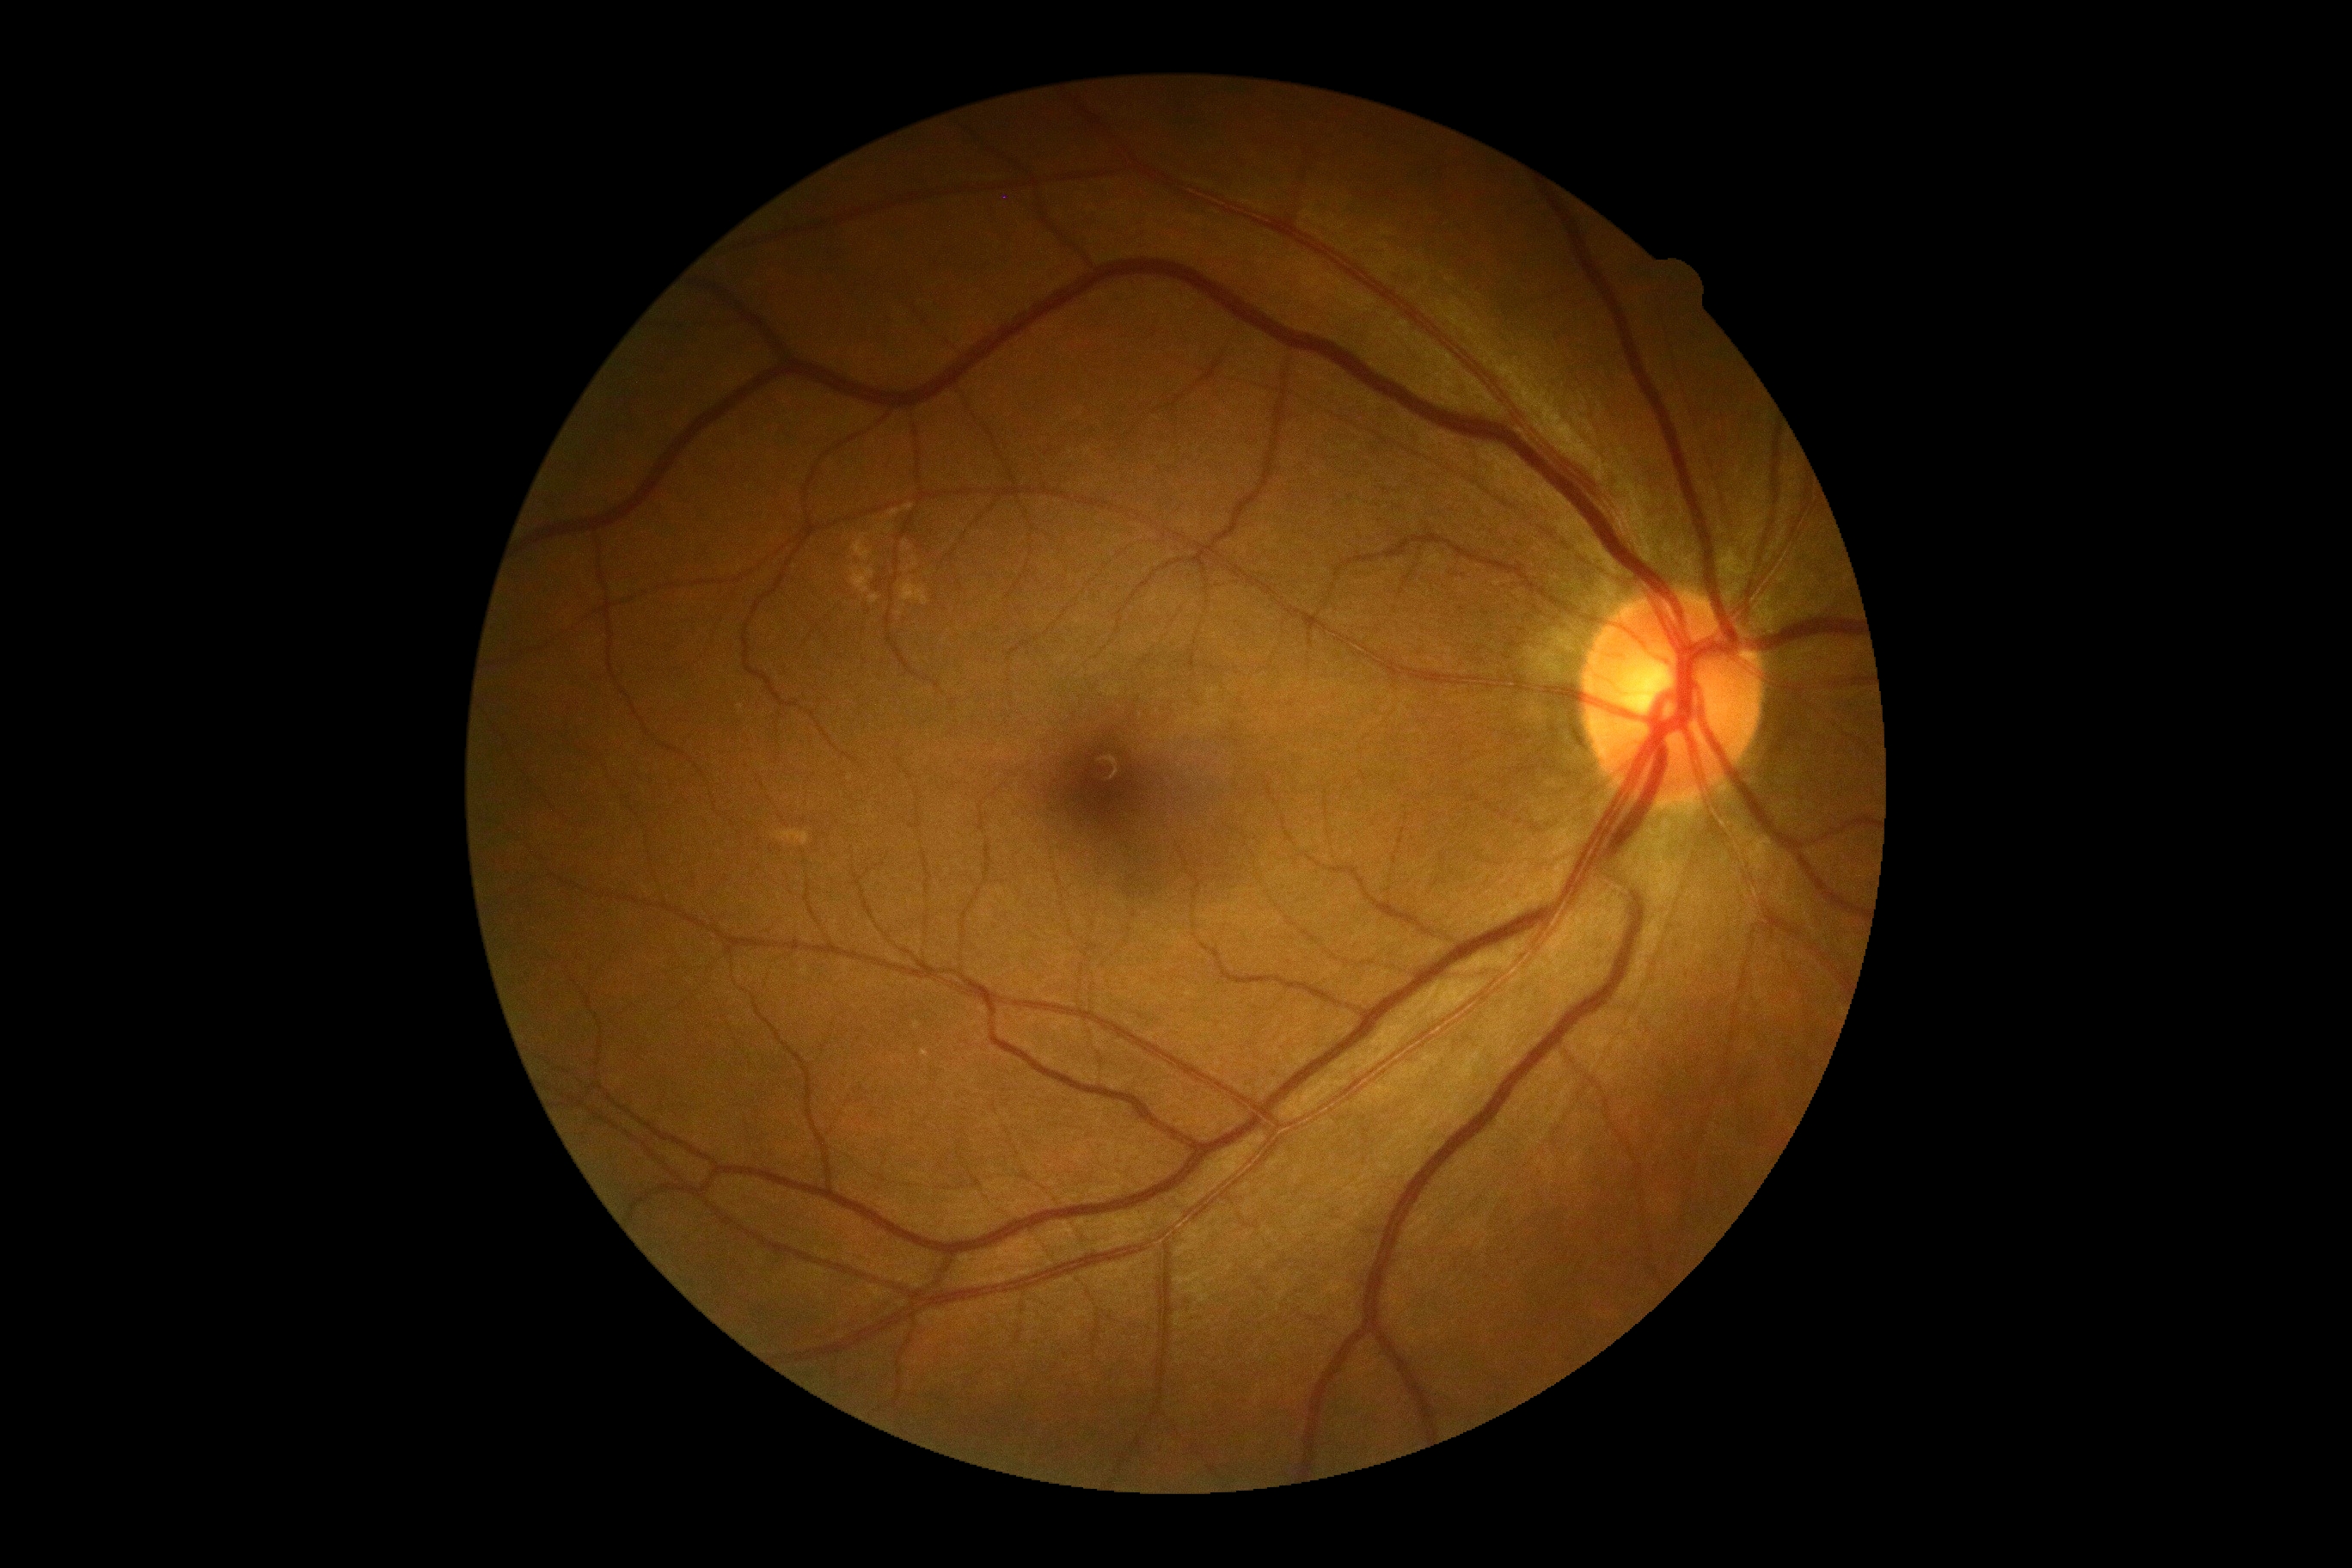
DR grade is 0/4. No signs of diabetic retinopathy.